CFP. FOV: 45 degrees
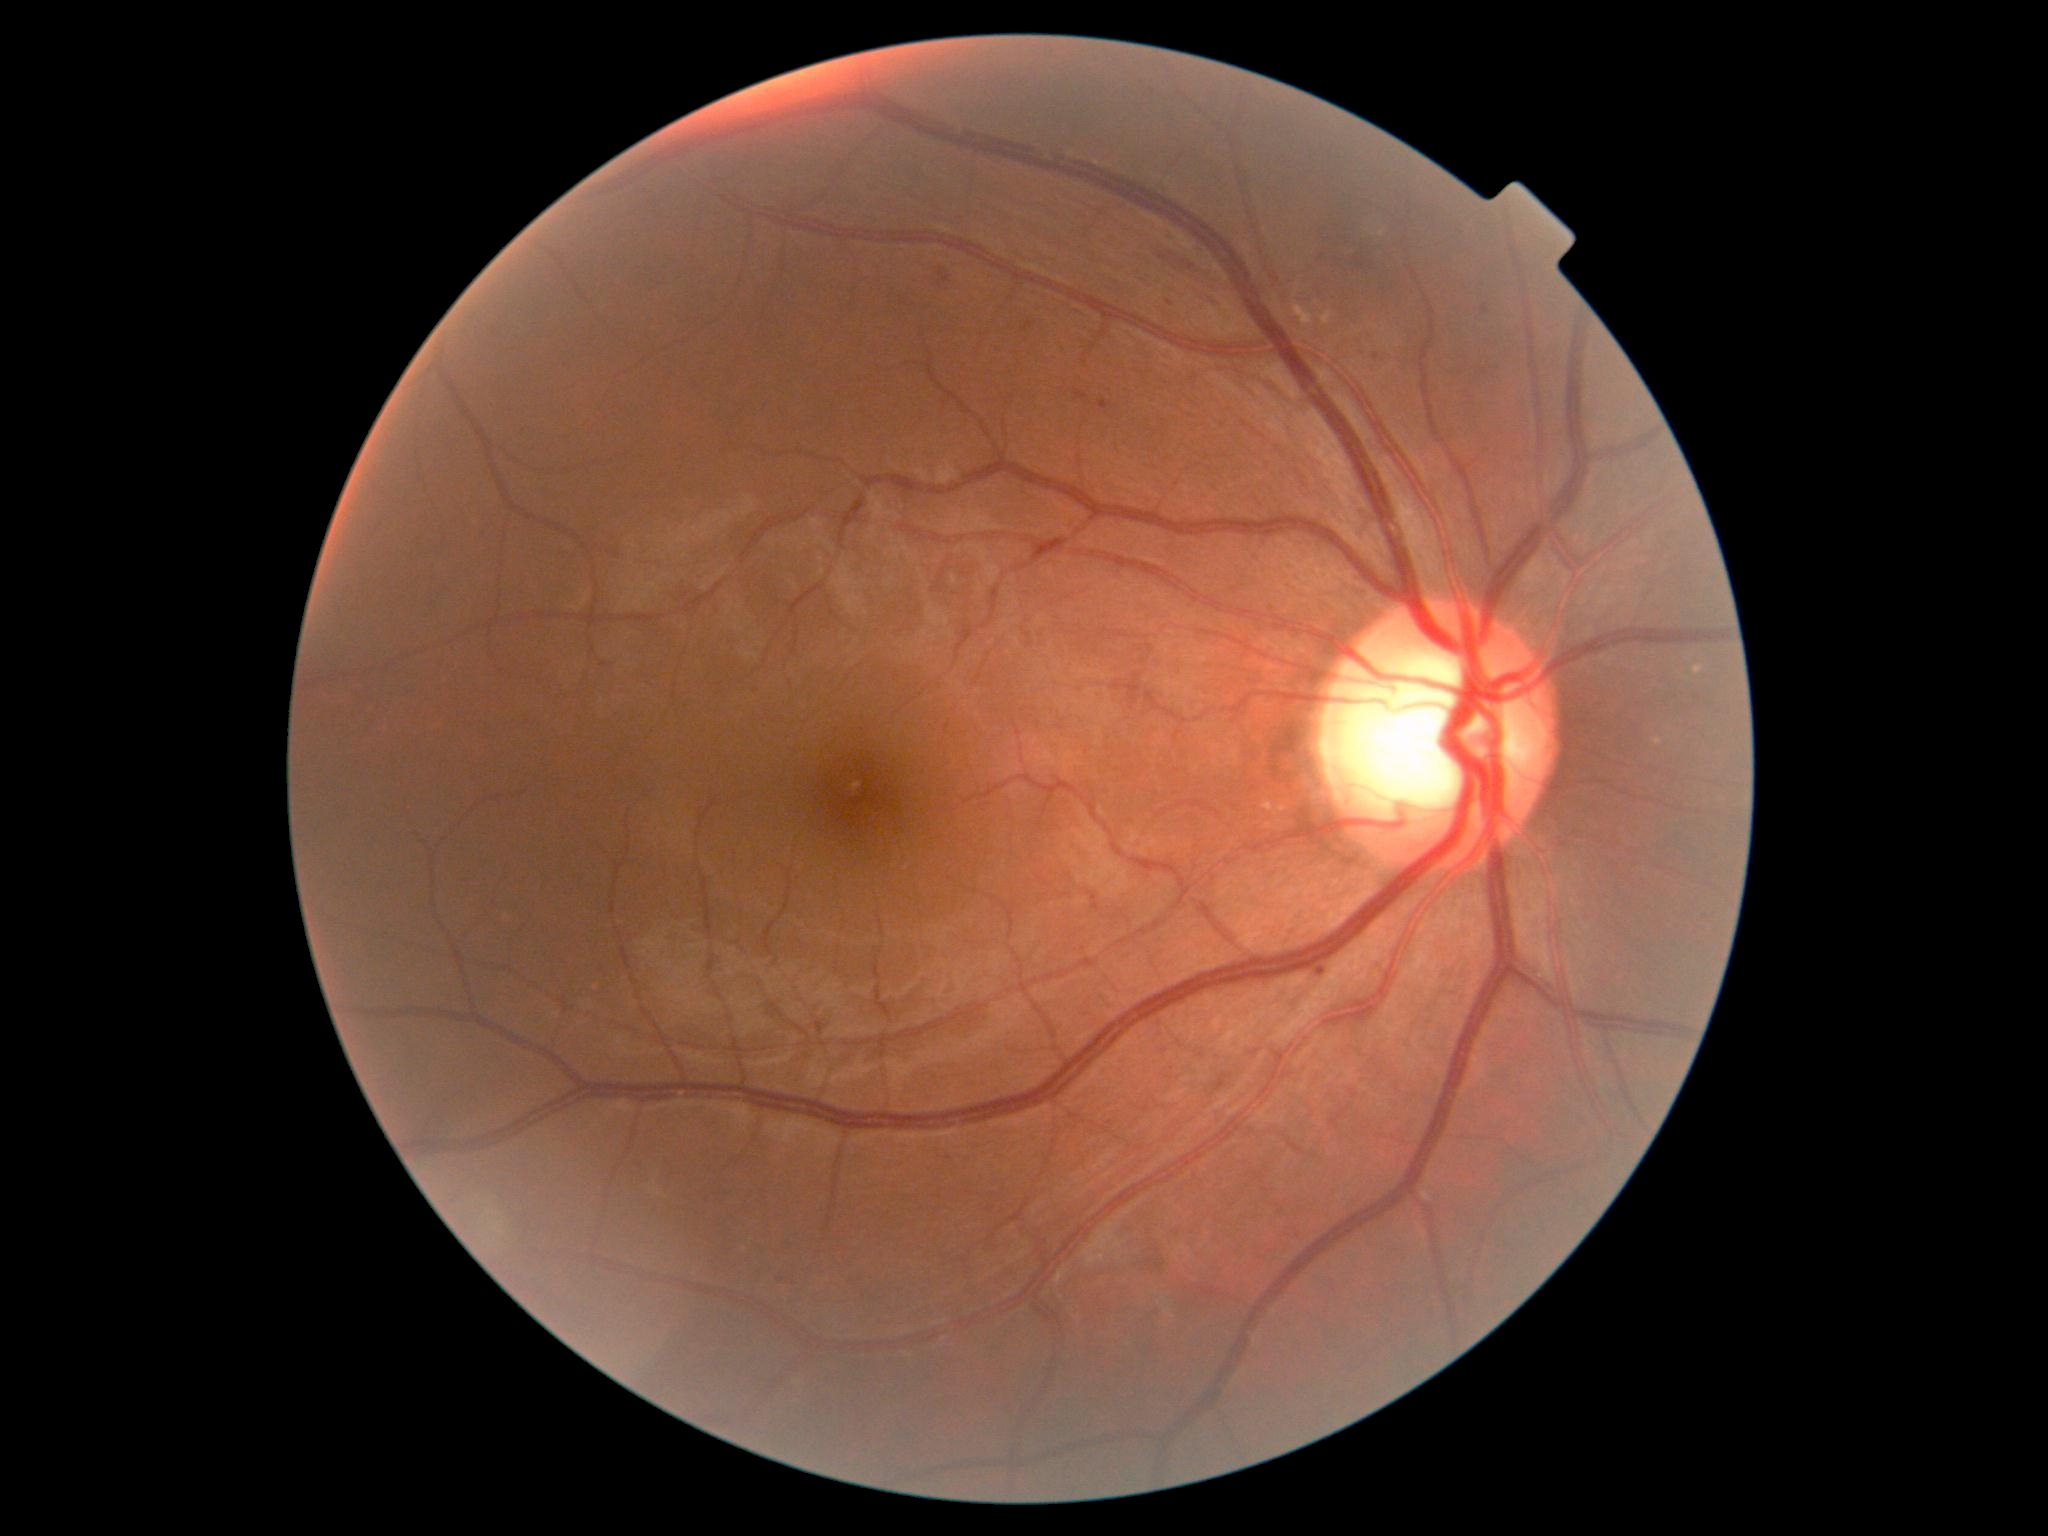

DR grade = 2 | DR class = non-proliferative diabetic retinopathy.